Fundus photo. 2352 x 1568 pixels. 45° field of view — 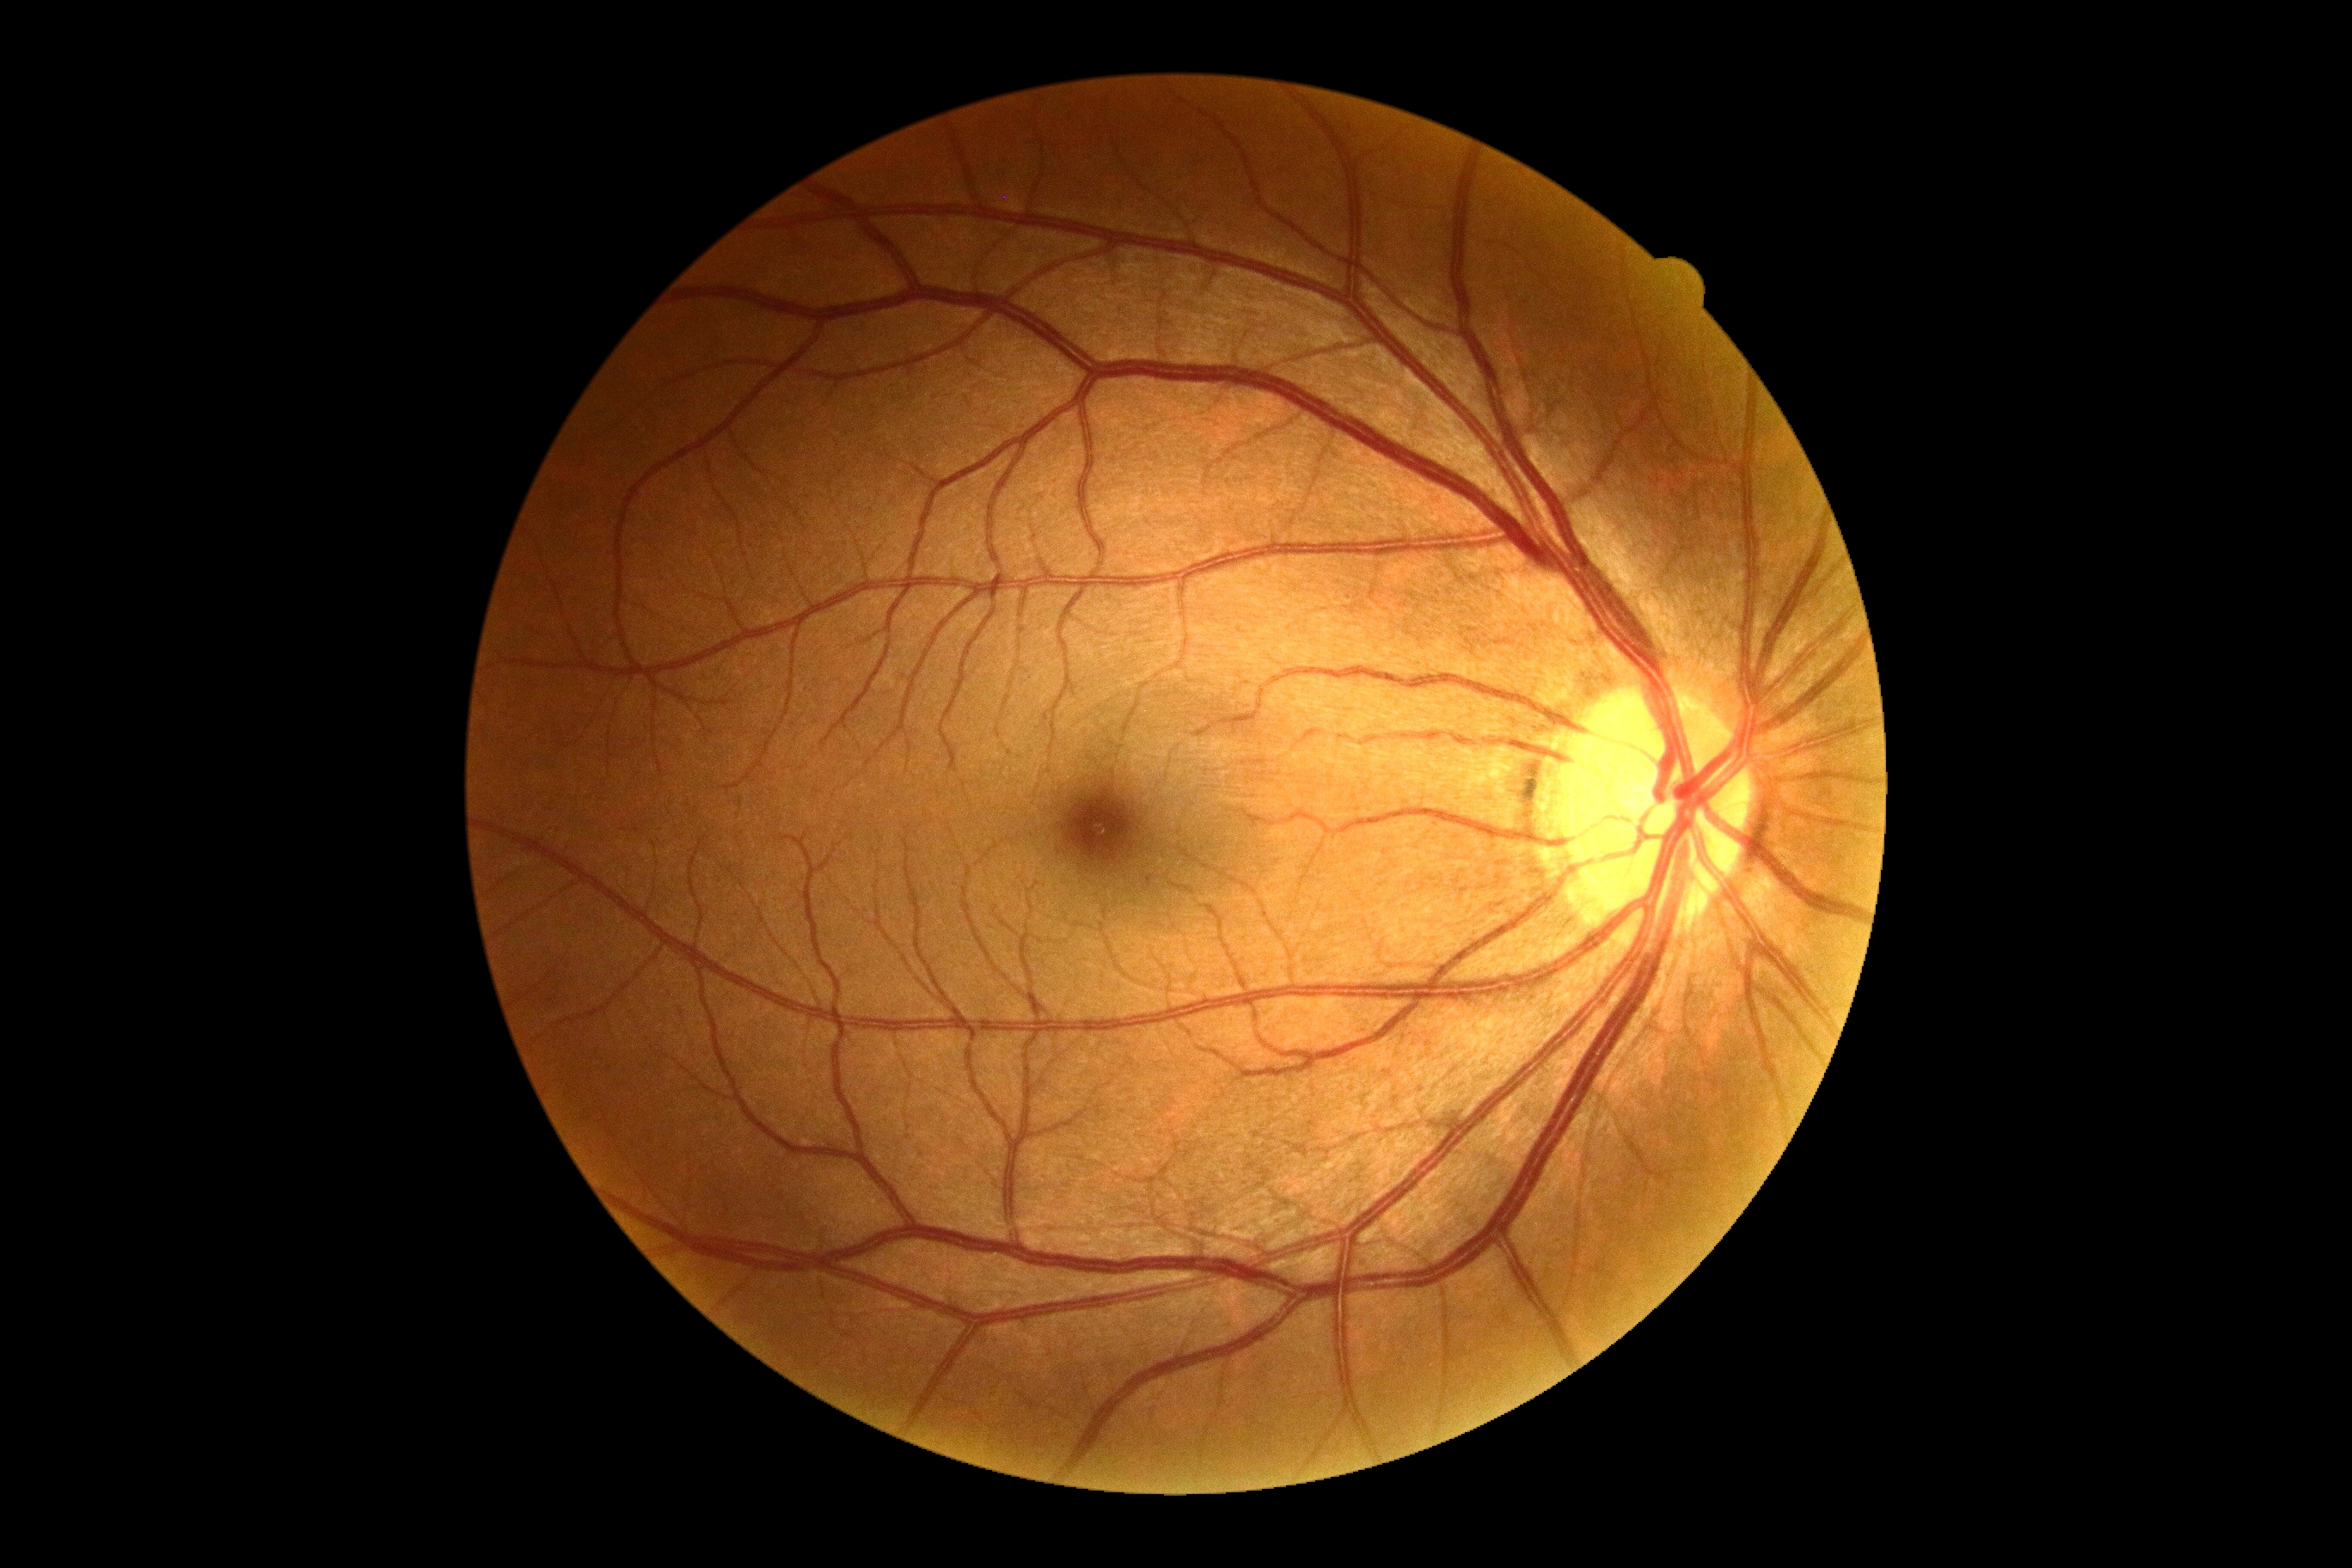 DR severity: grade 0 (no apparent retinopathy) — no visible signs of diabetic retinopathy.